Graded on the modified Davis scale; NIDEK AFC-230:
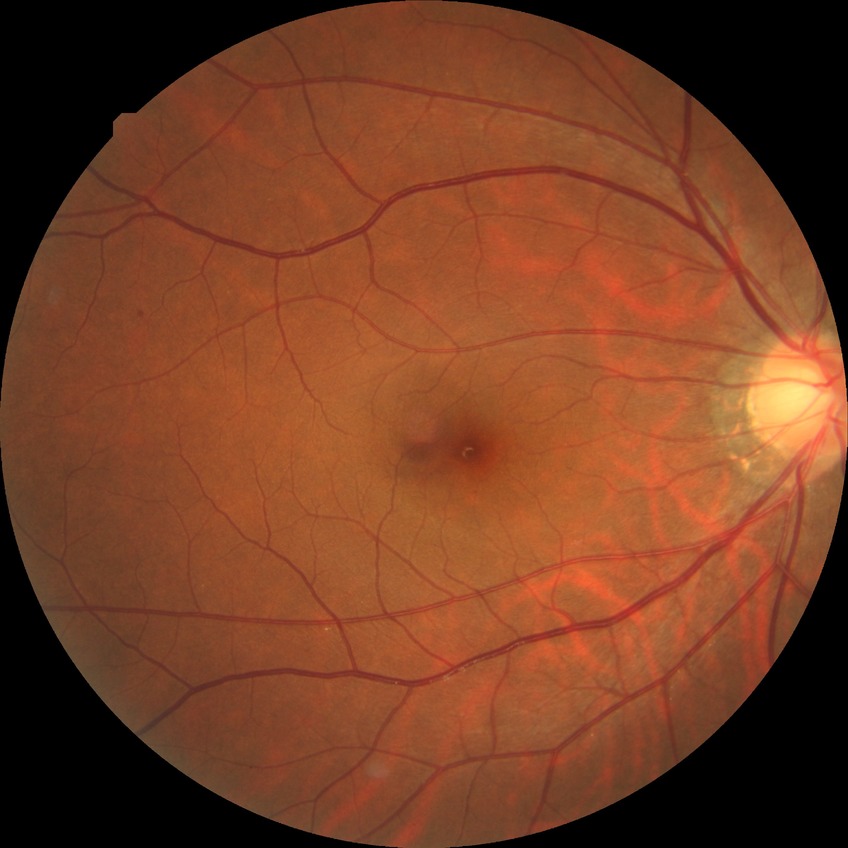

Diabetic retinopathy (DR) is NDR (no diabetic retinopathy).